Modified Davis classification.
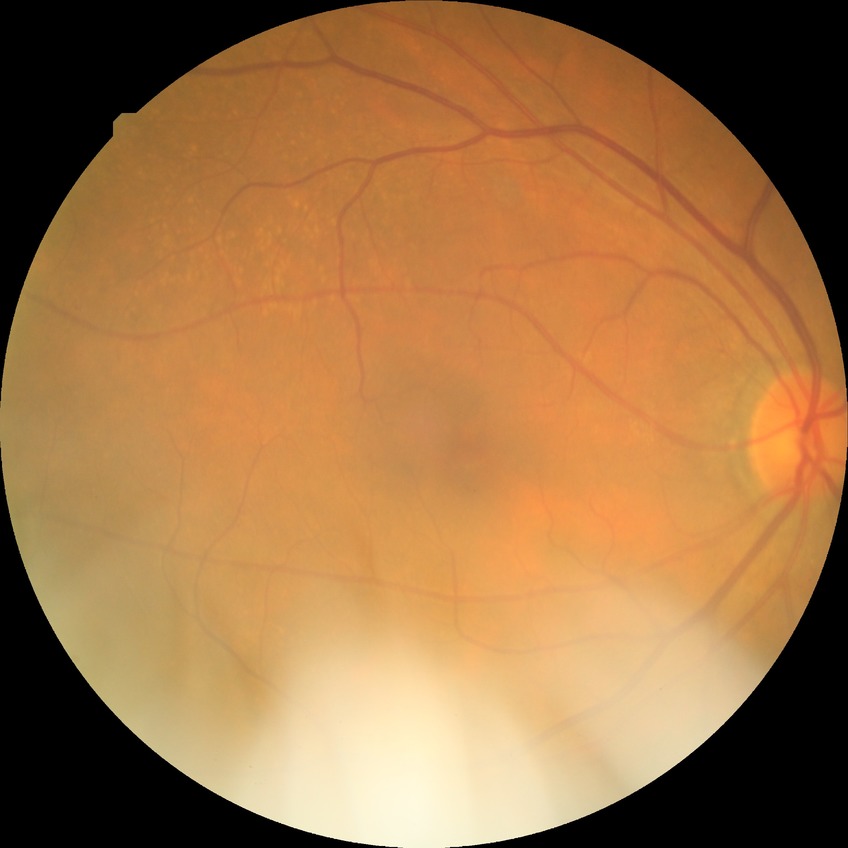

diabetic retinopathy stage@simple diabetic retinopathy.